45-degree field of view, graded on the modified Davis scale, NIDEK AFC-230, nonmydriatic fundus photograph:
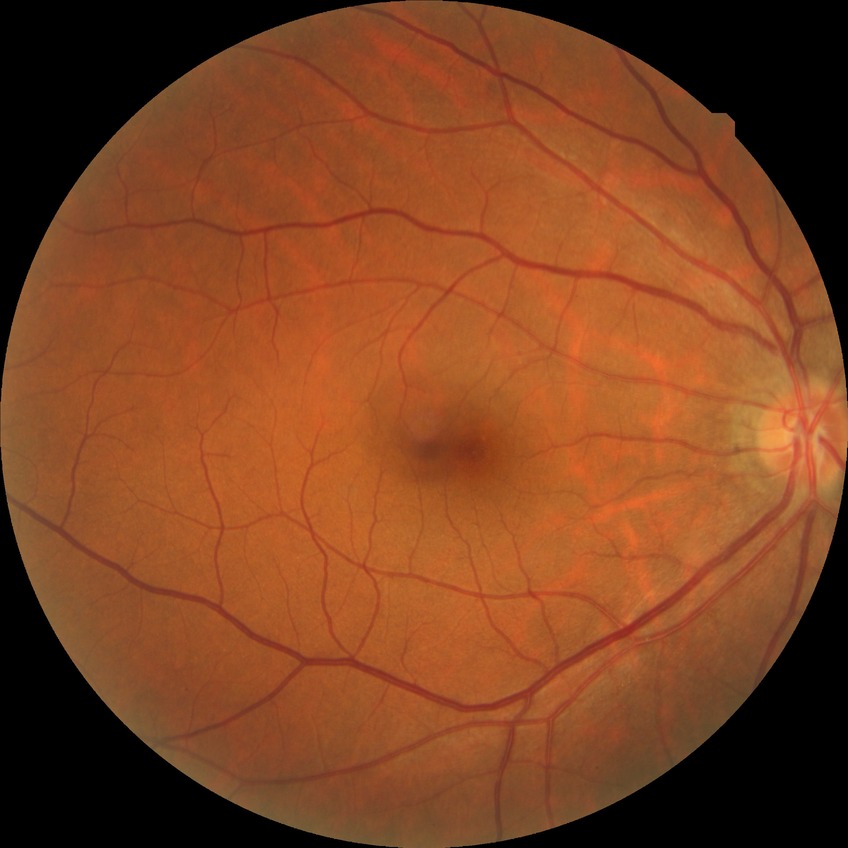
Davis grade: NDR.
No DR findings.